45° field of view, diabetic retinopathy graded by the modified Davis classification
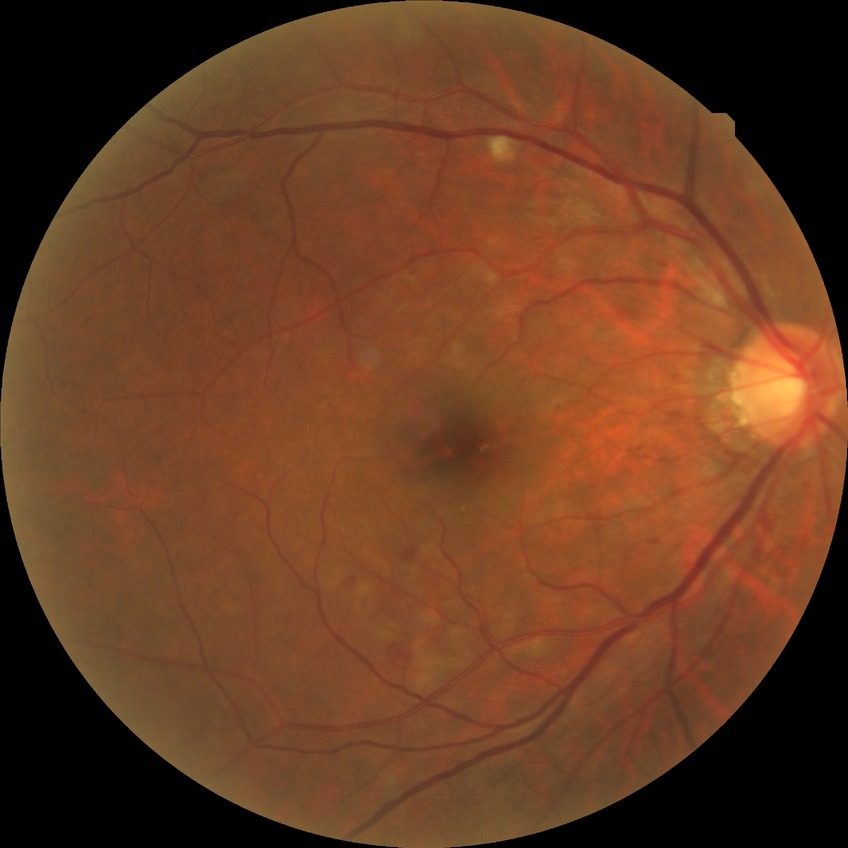 Modified Davis classification: simple diabetic retinopathy.